CFP, central posterior field, 2228x1652, 50-degree field of view, captured after pupil dilation — 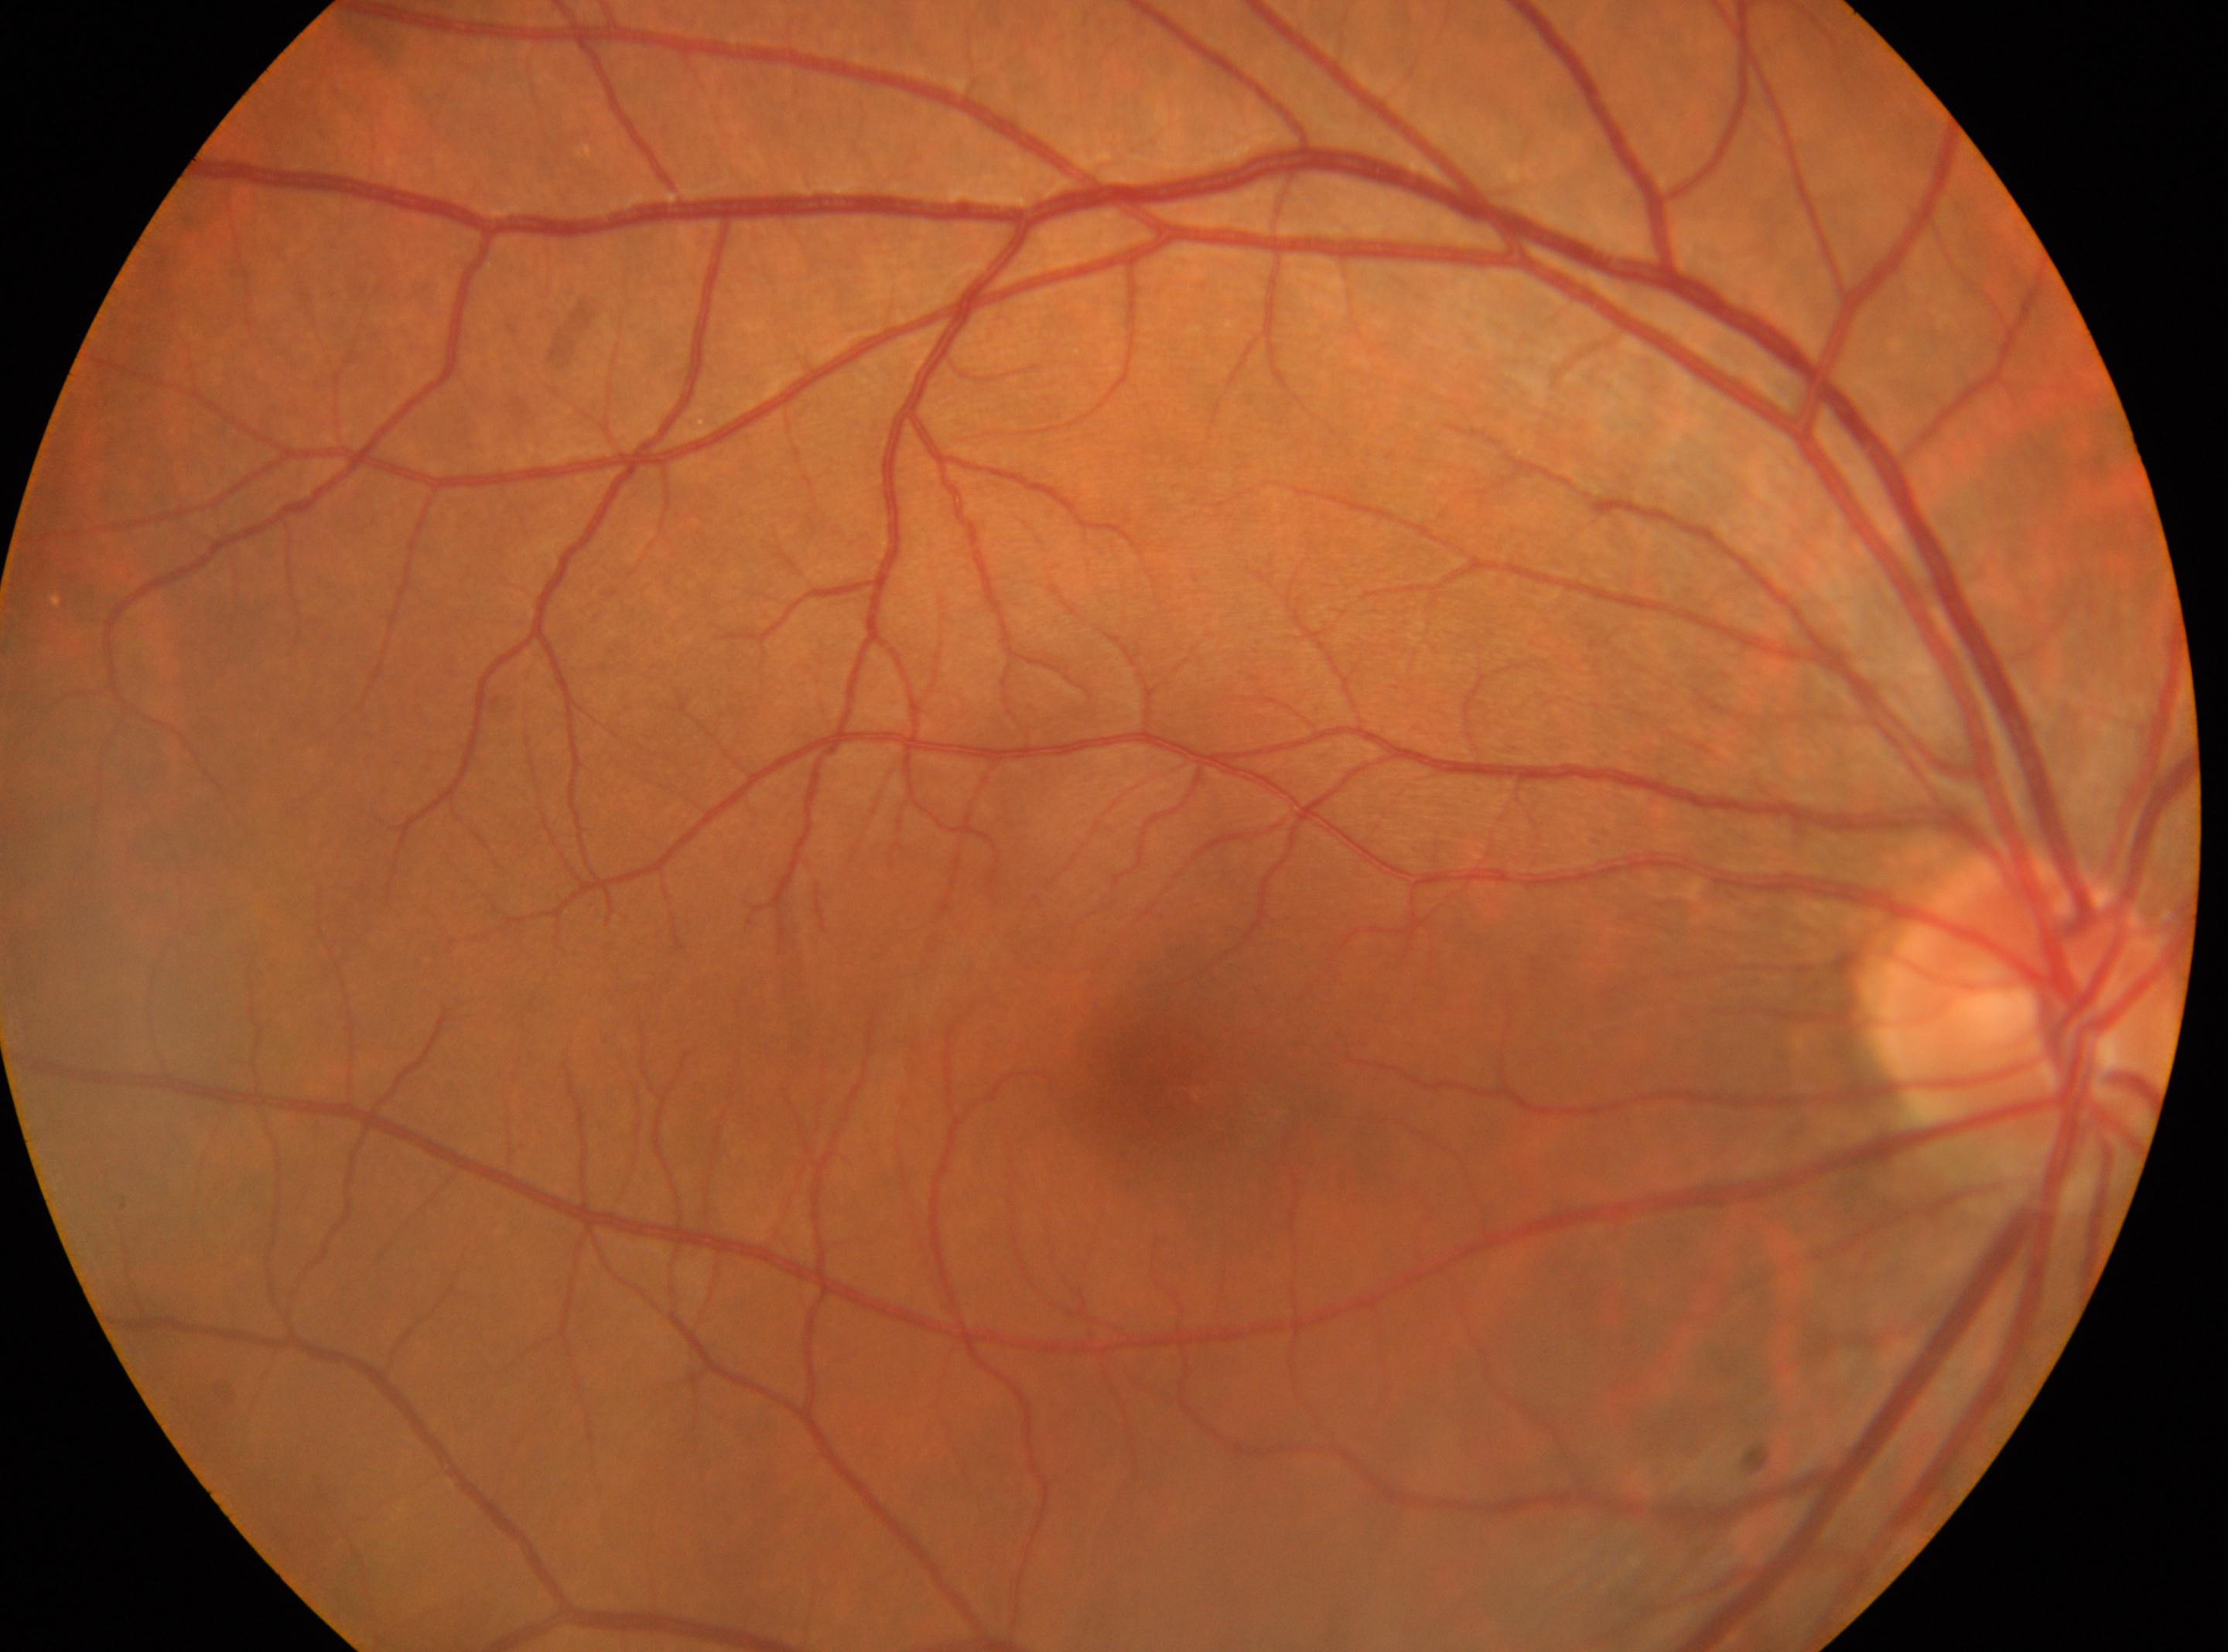

Q: Fovea center?
A: x=1193, y=1091
Q: DR stage?
A: 0/4 — no visible signs of diabetic retinopathy
Q: Which eye is imaged?
A: oculus dexter
Q: Locate the optic disc.
A: x=2032, y=1003